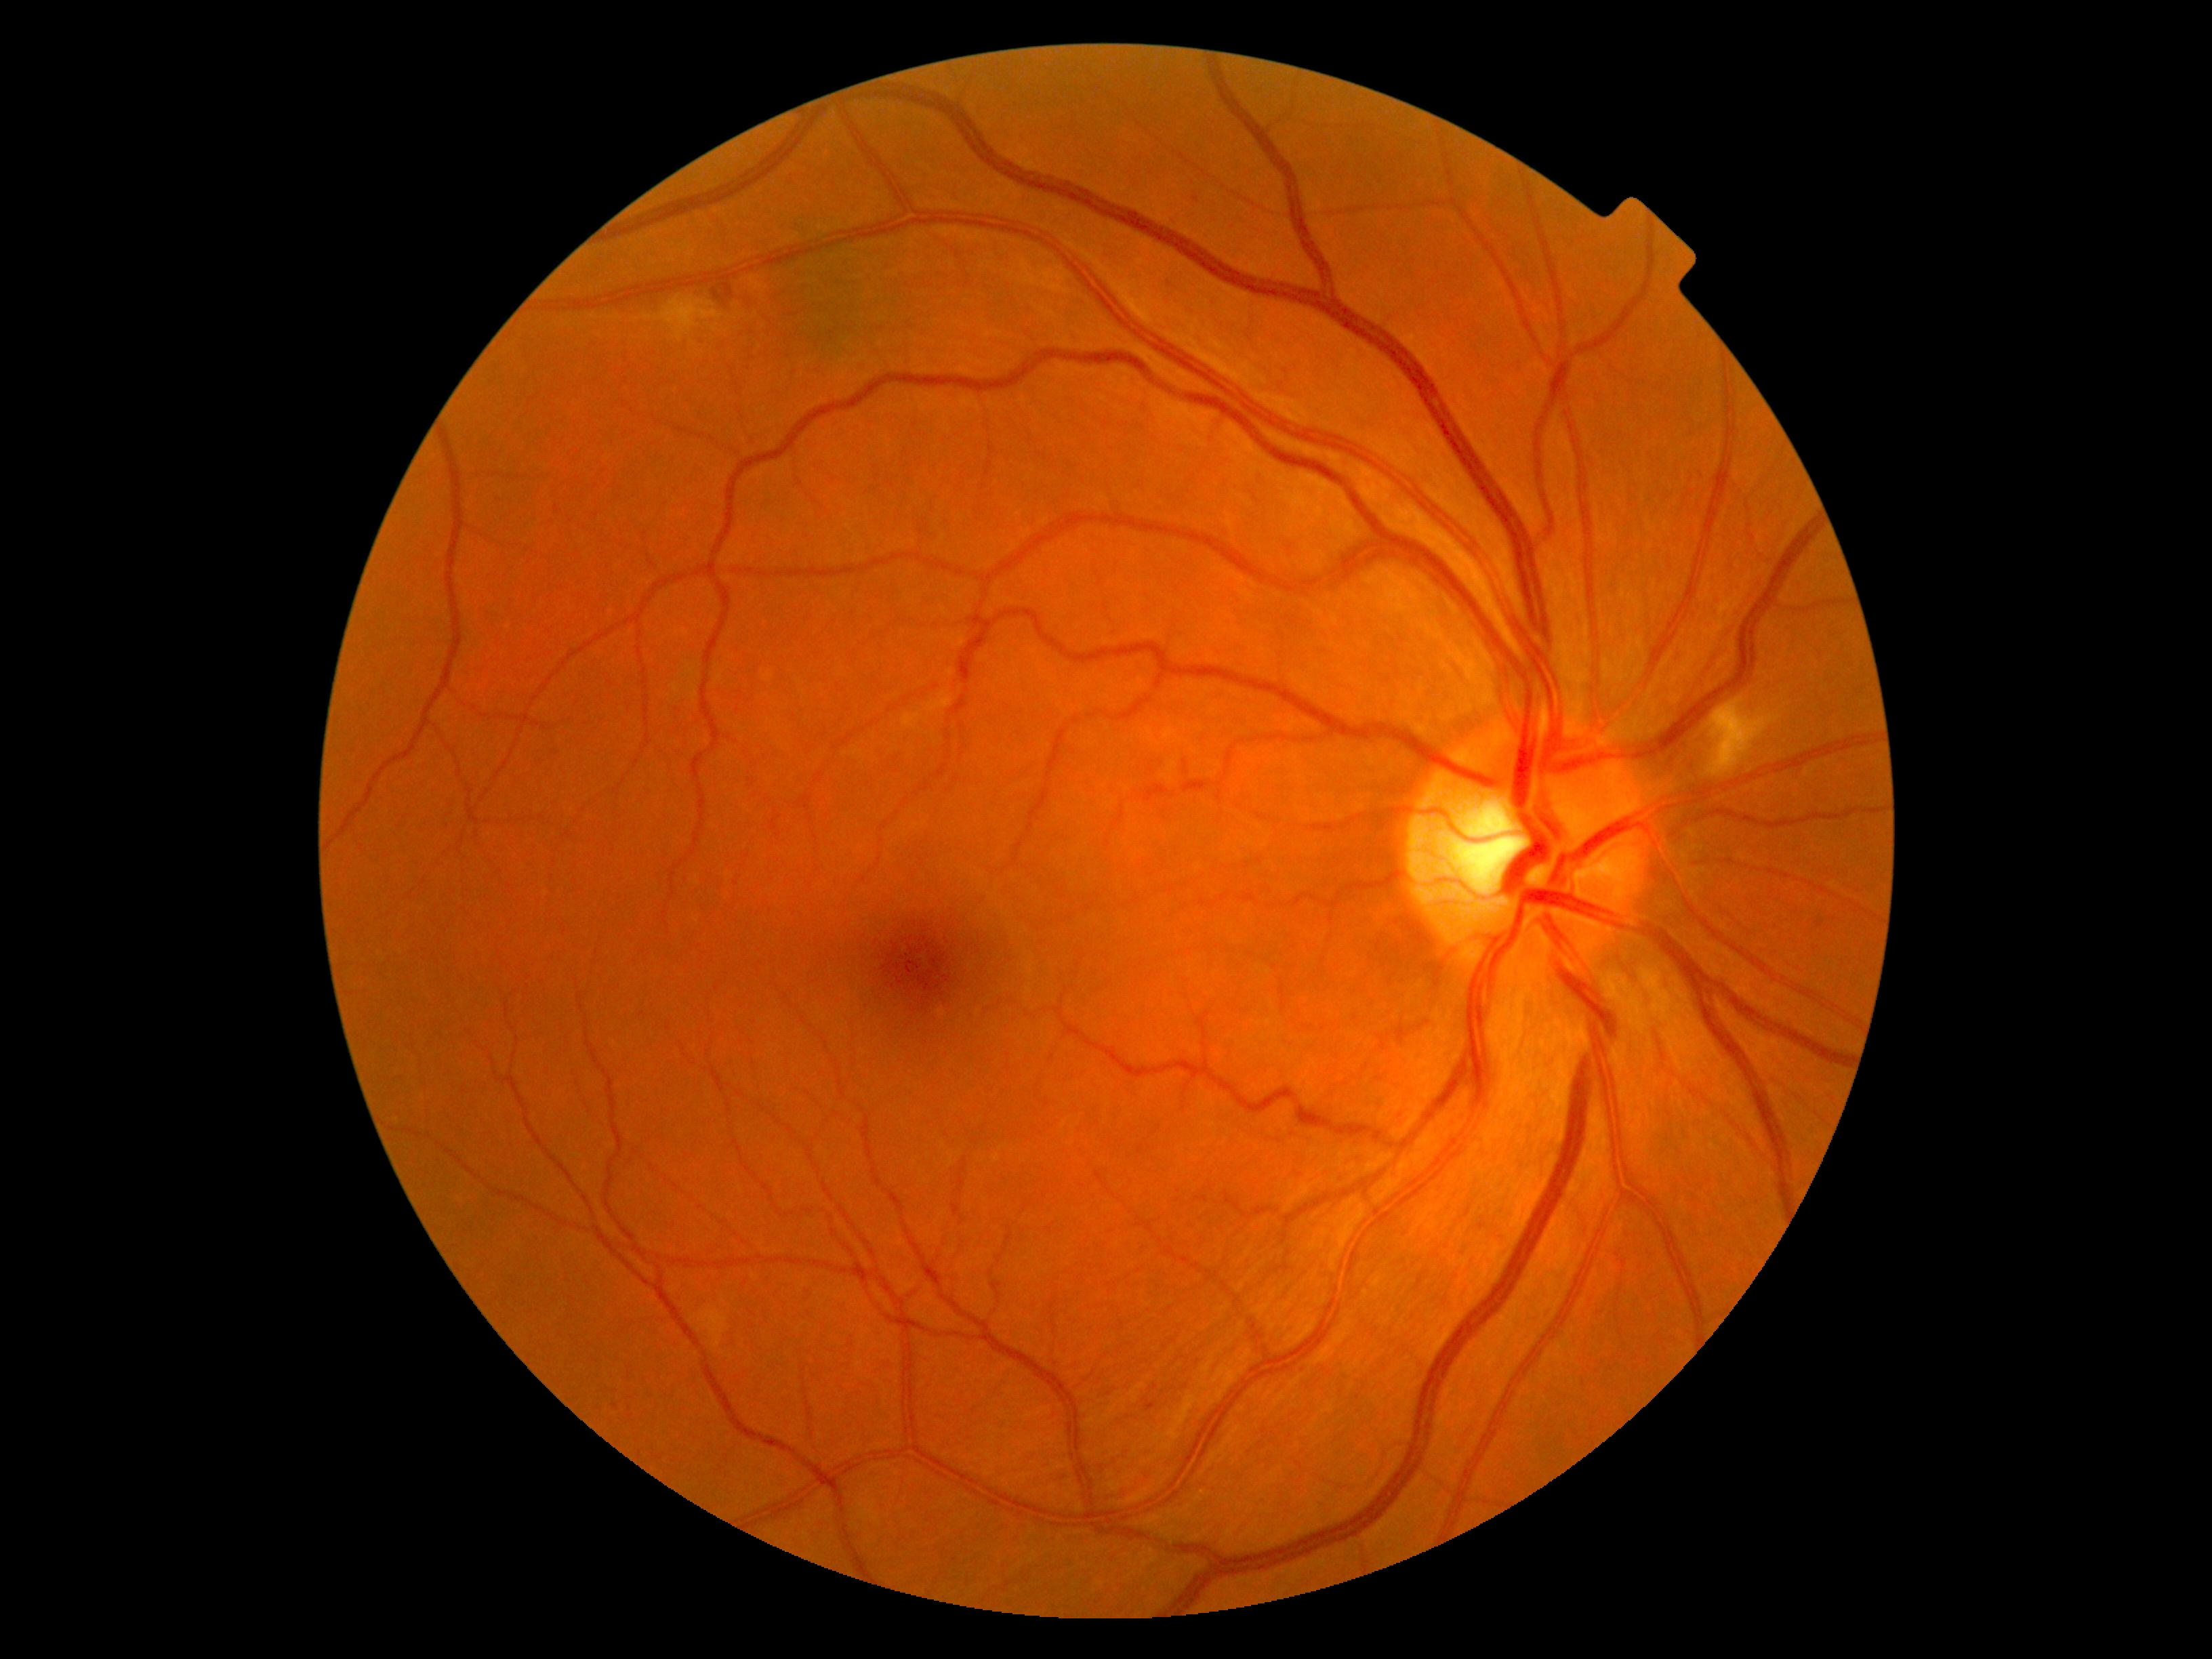

dr_grade: 2 (moderate NPDR)
dr_category: non-proliferative diabetic retinopathy